1240 x 1240 pixels · pediatric wide-field fundus photograph:
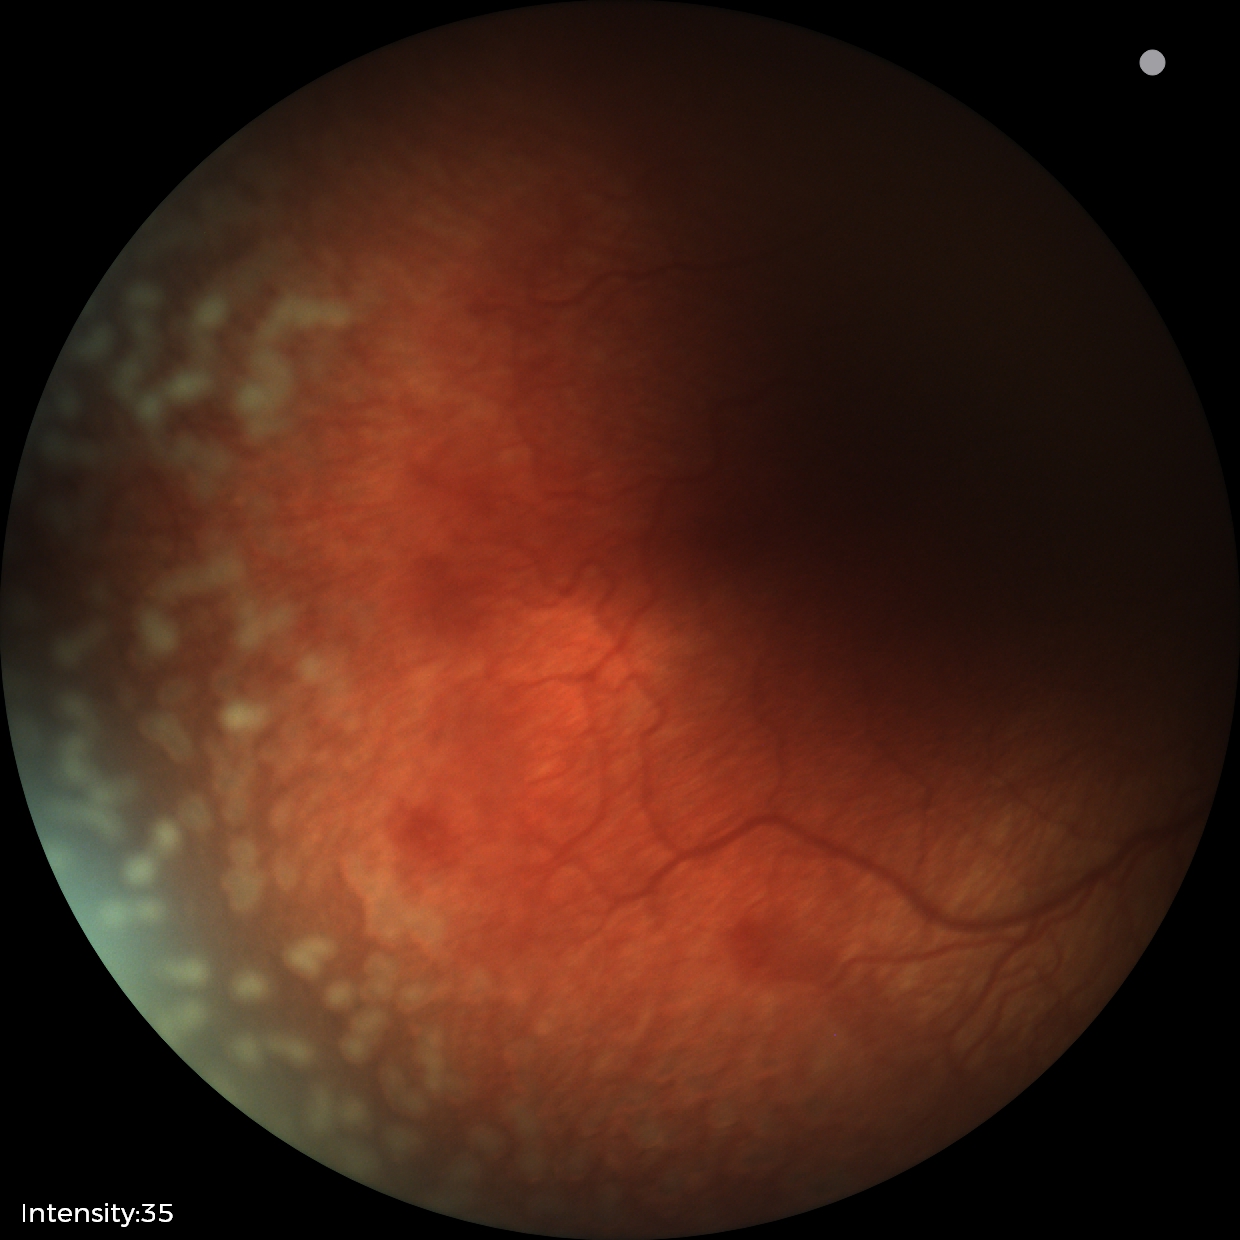
Plus disease was diagnosed. Examination diagnosed as retinopathy of prematurity stage 2 — ridge with height and width at the demarcation line.